RetCam wide-field infant fundus image — 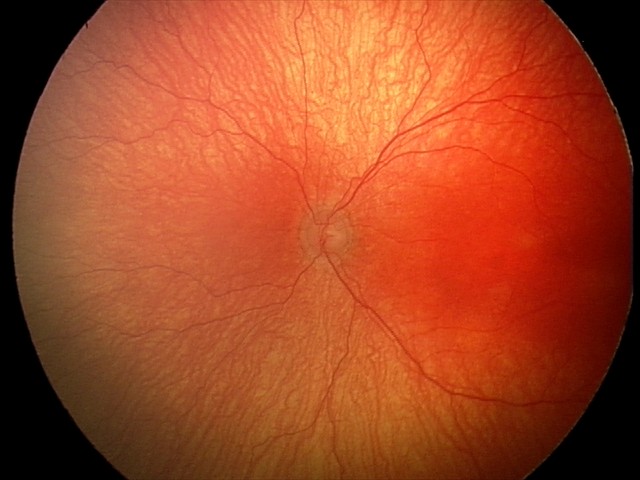 Series diagnosed as aggressive retinopathy of prematurity (A-ROP).